Handheld portable fundus camera image, 60° field of view, image size 2212x1659 — 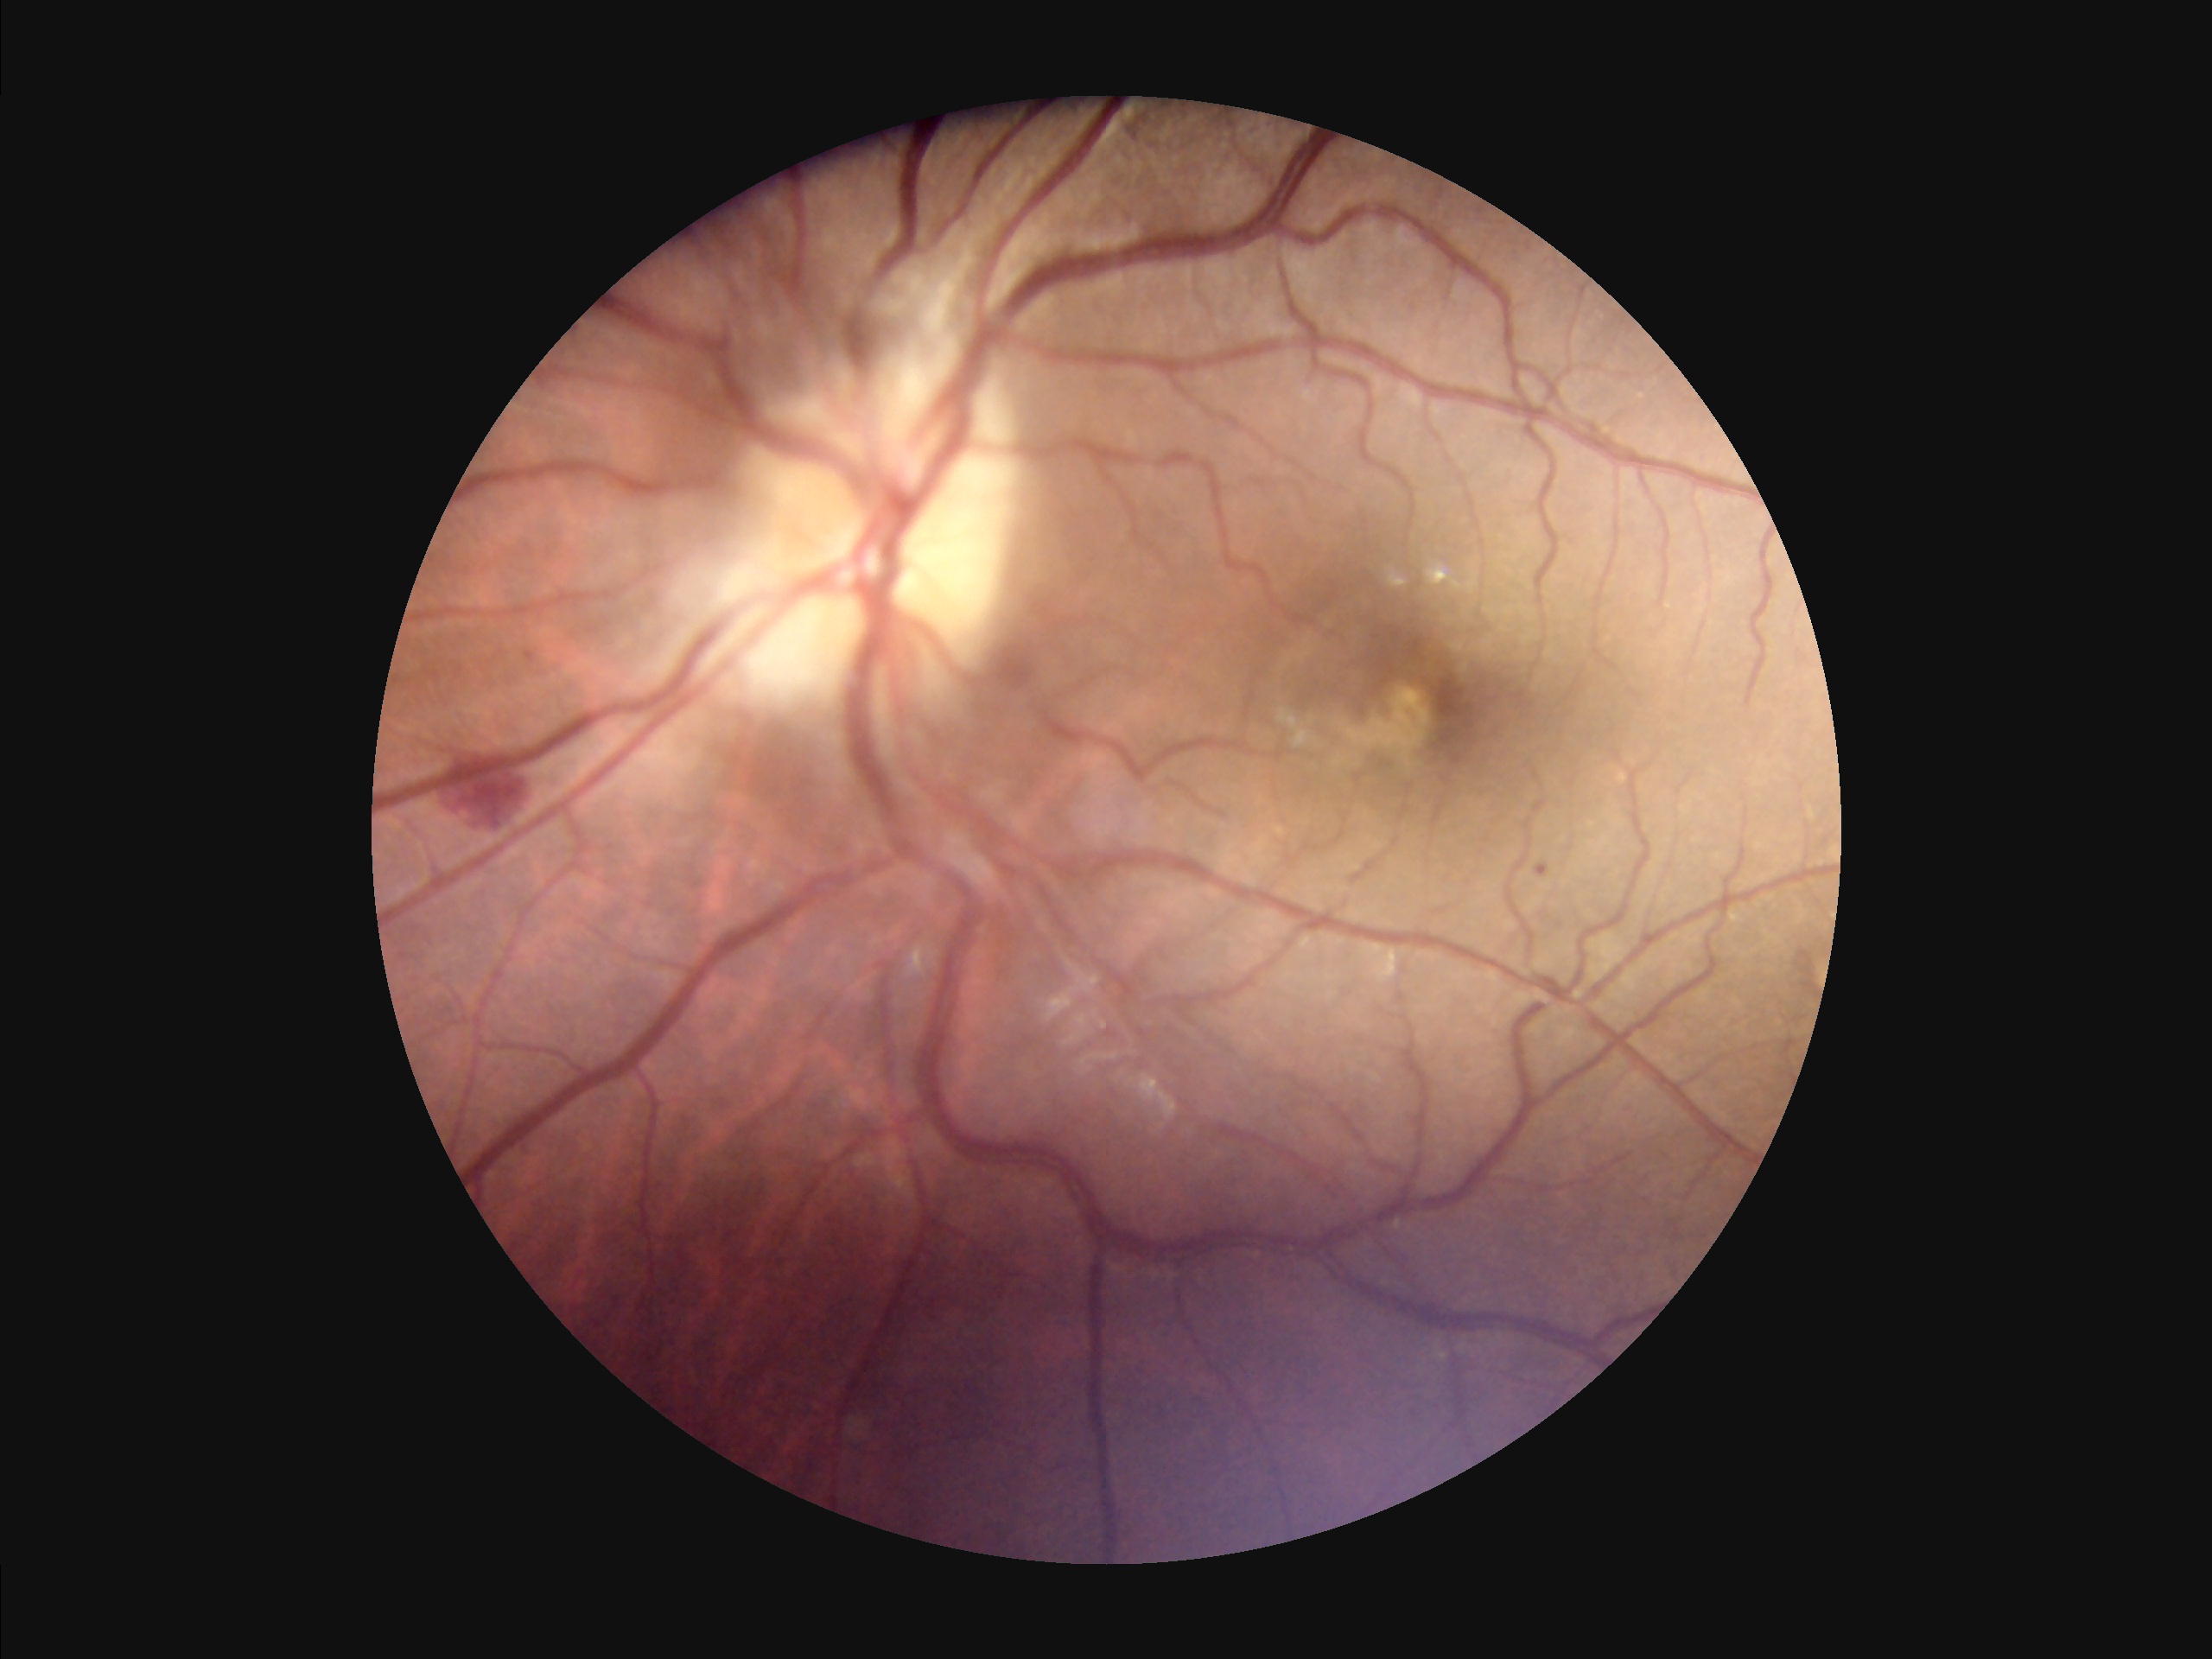 {"clarity": "good", "overall_quality": "good", "illumination": "uneven"}